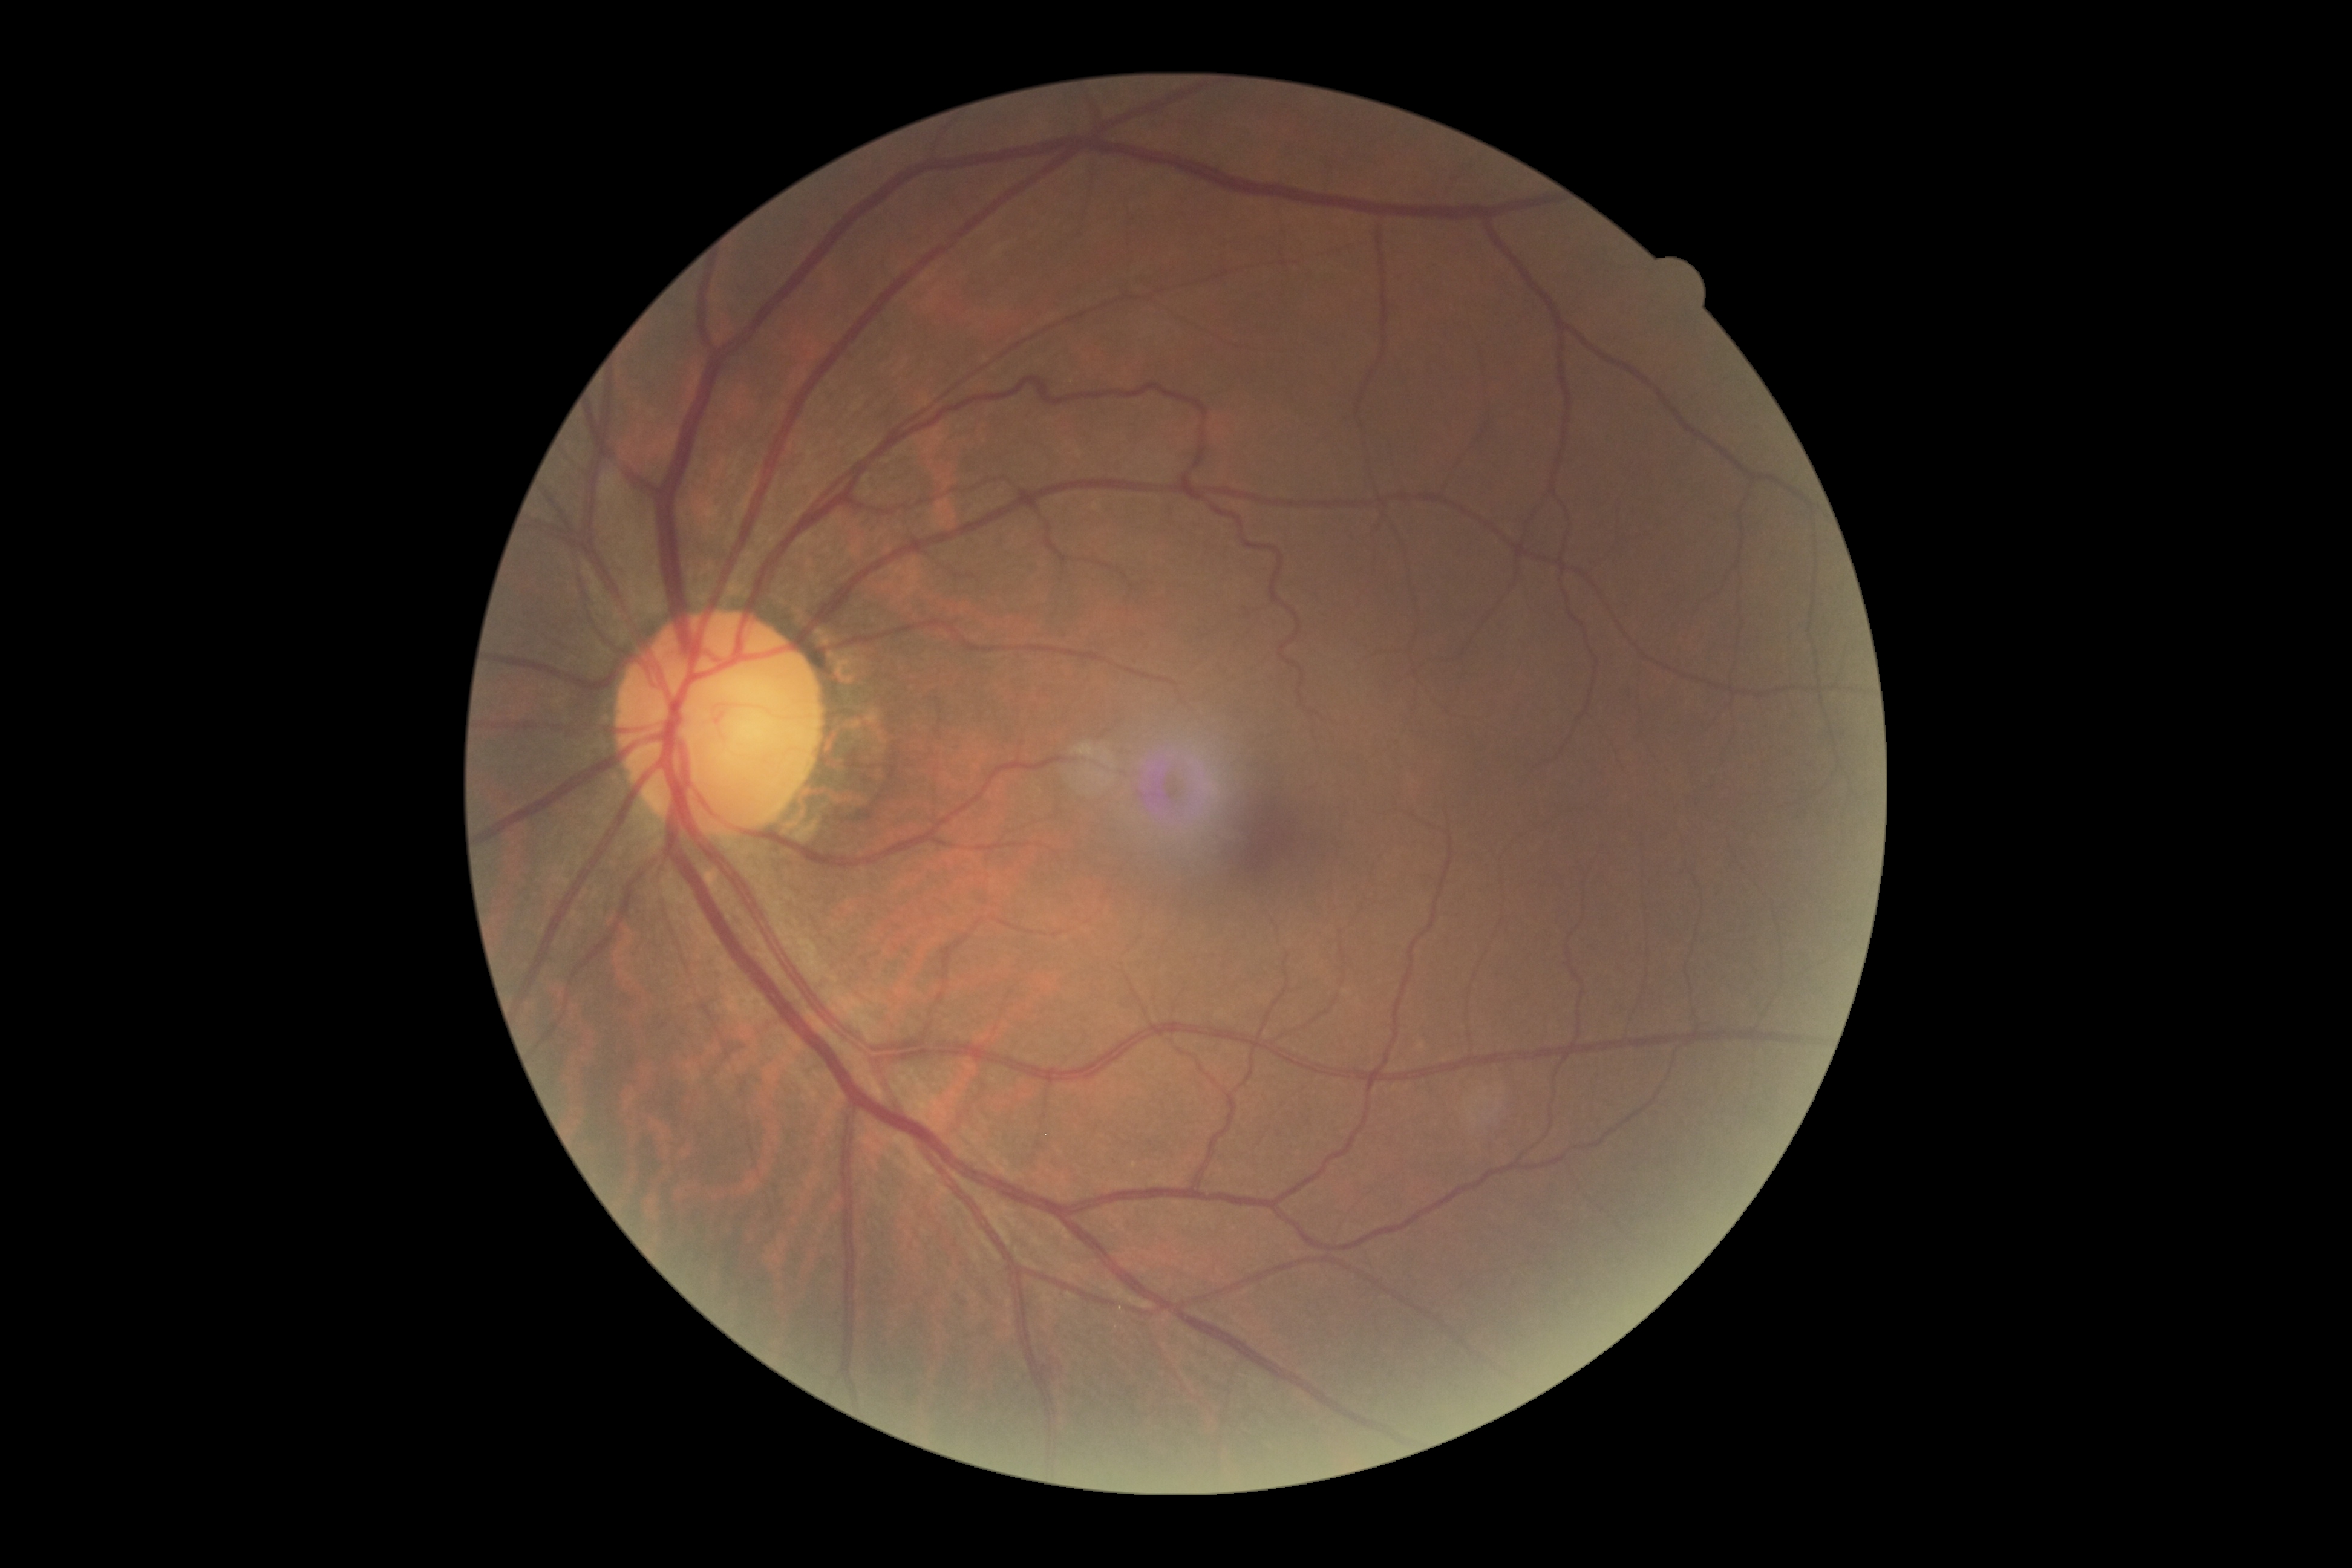
No DR findings. Diabetic retinopathy severity is grade 0.